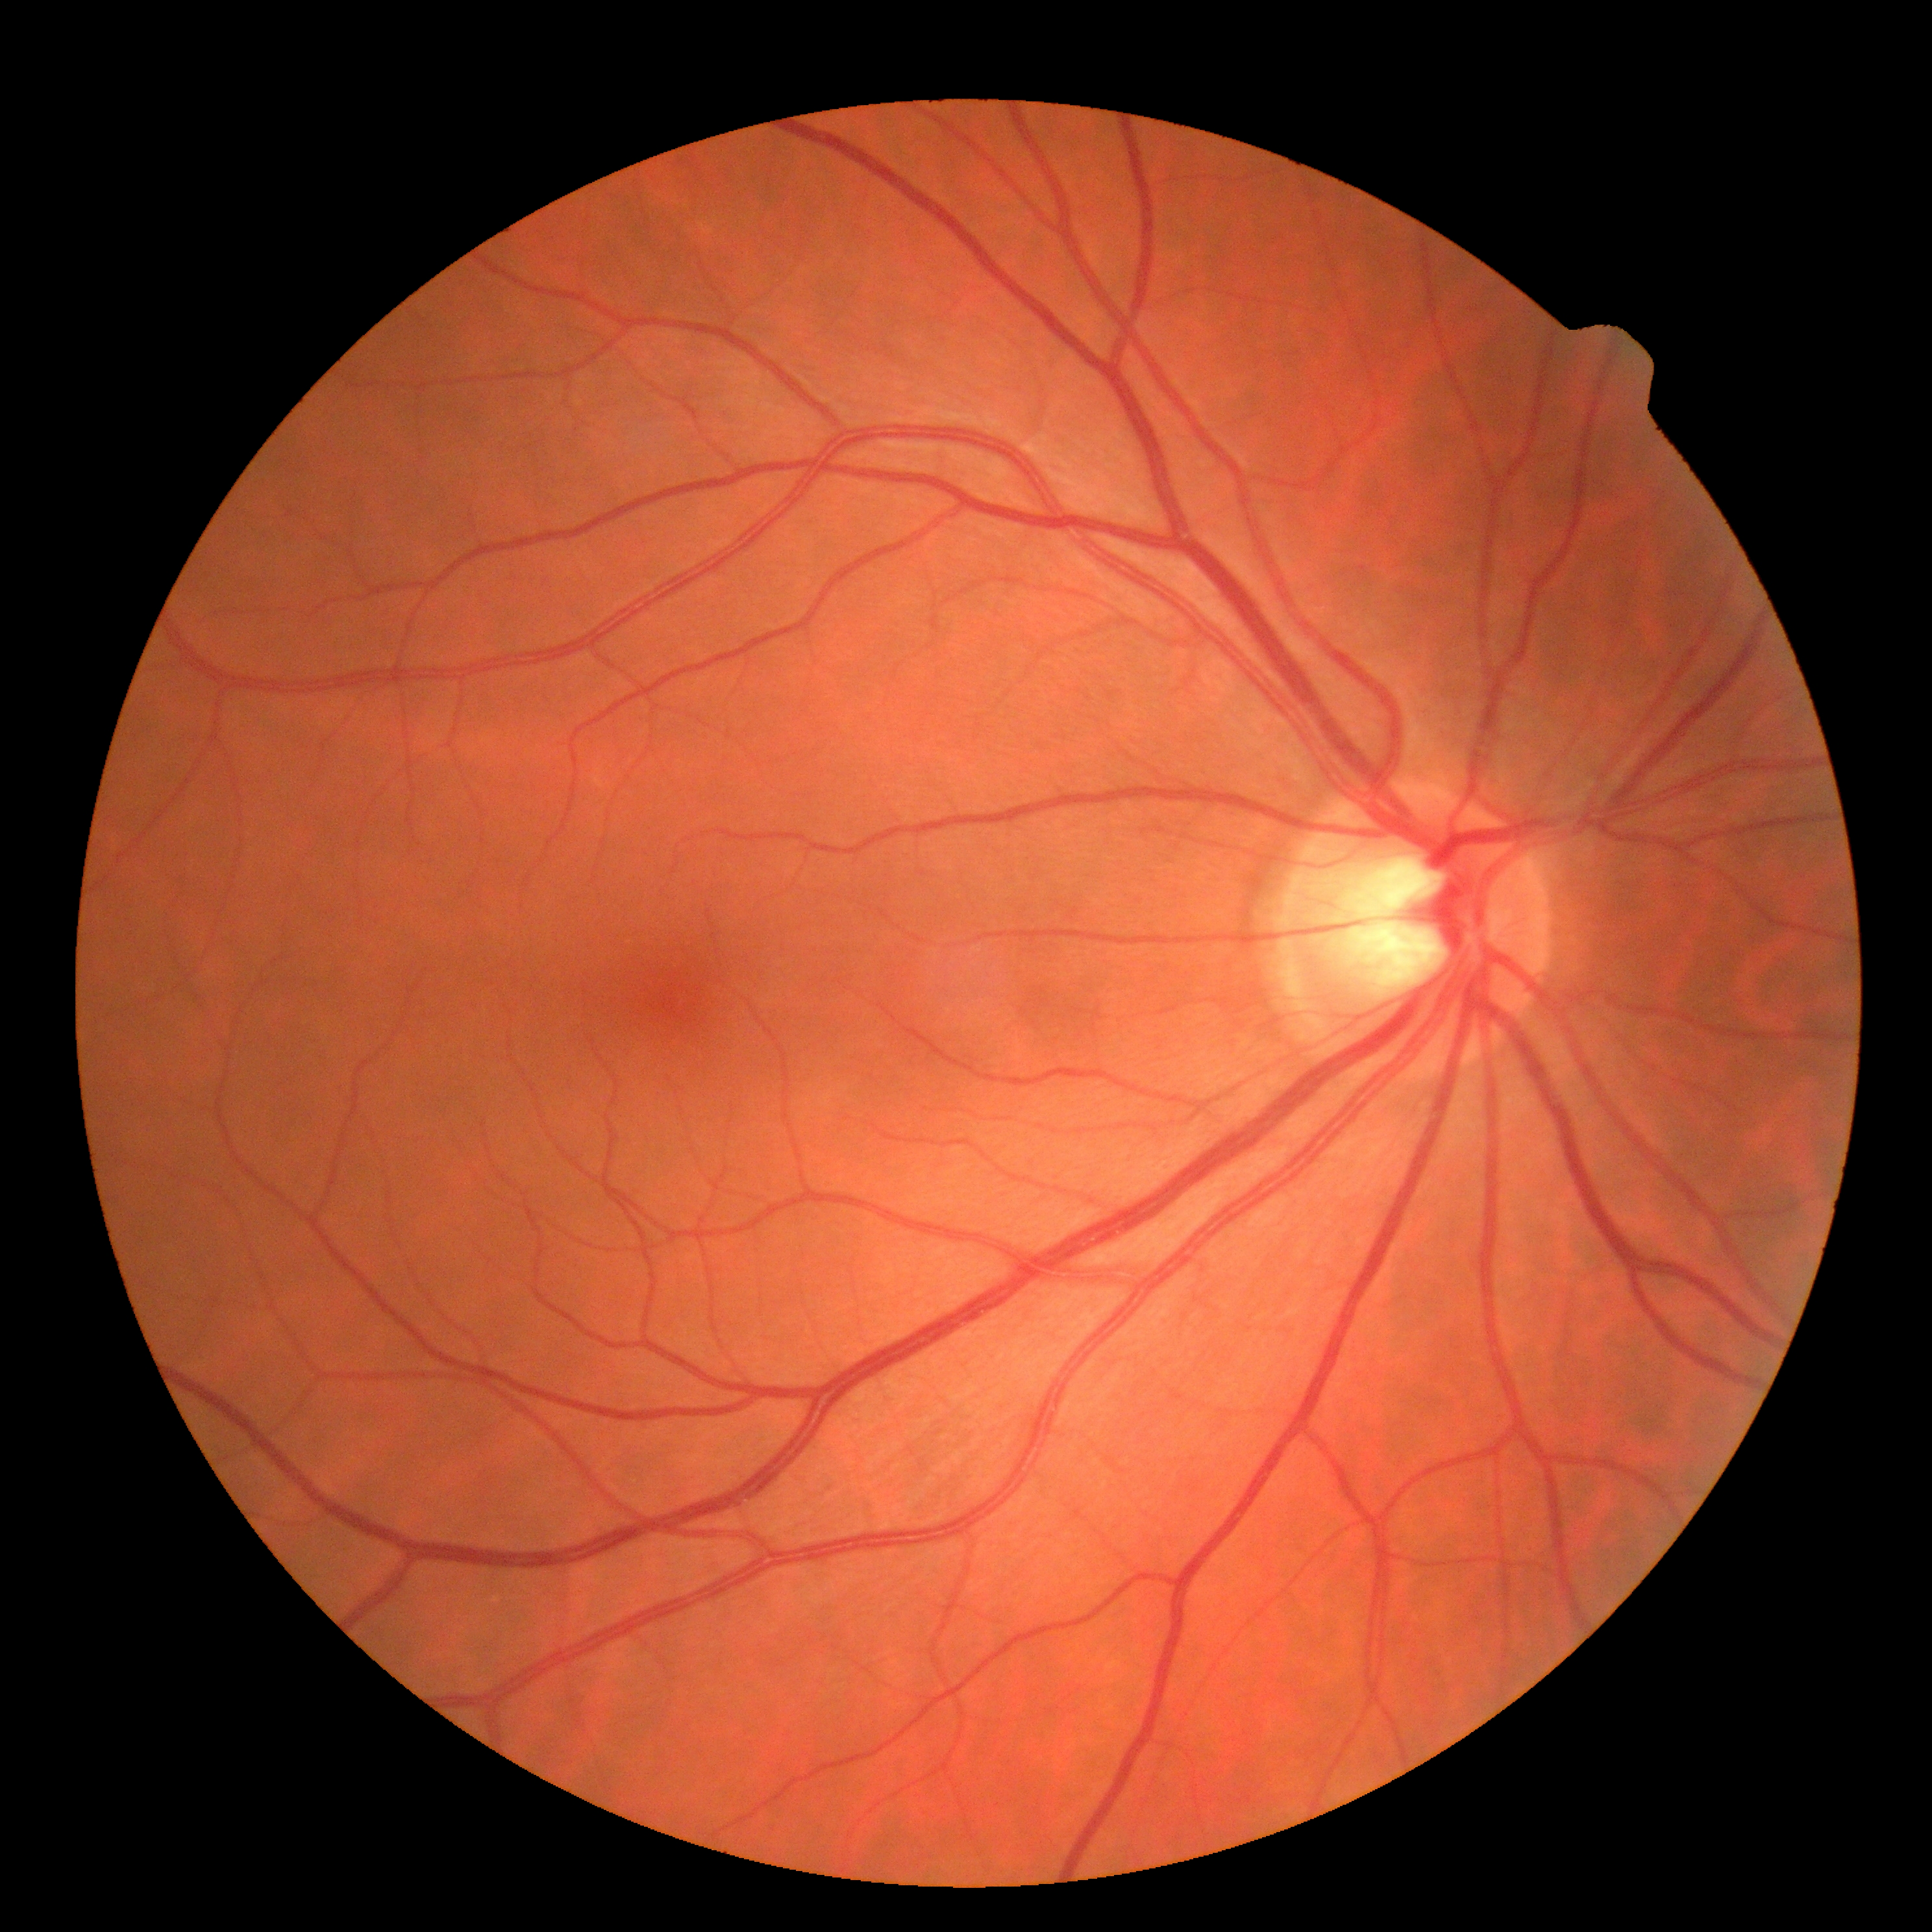 Retinopathy grade is no apparent retinopathy (0). No DR findings.